Retinal fundus photograph · 1659x2212:
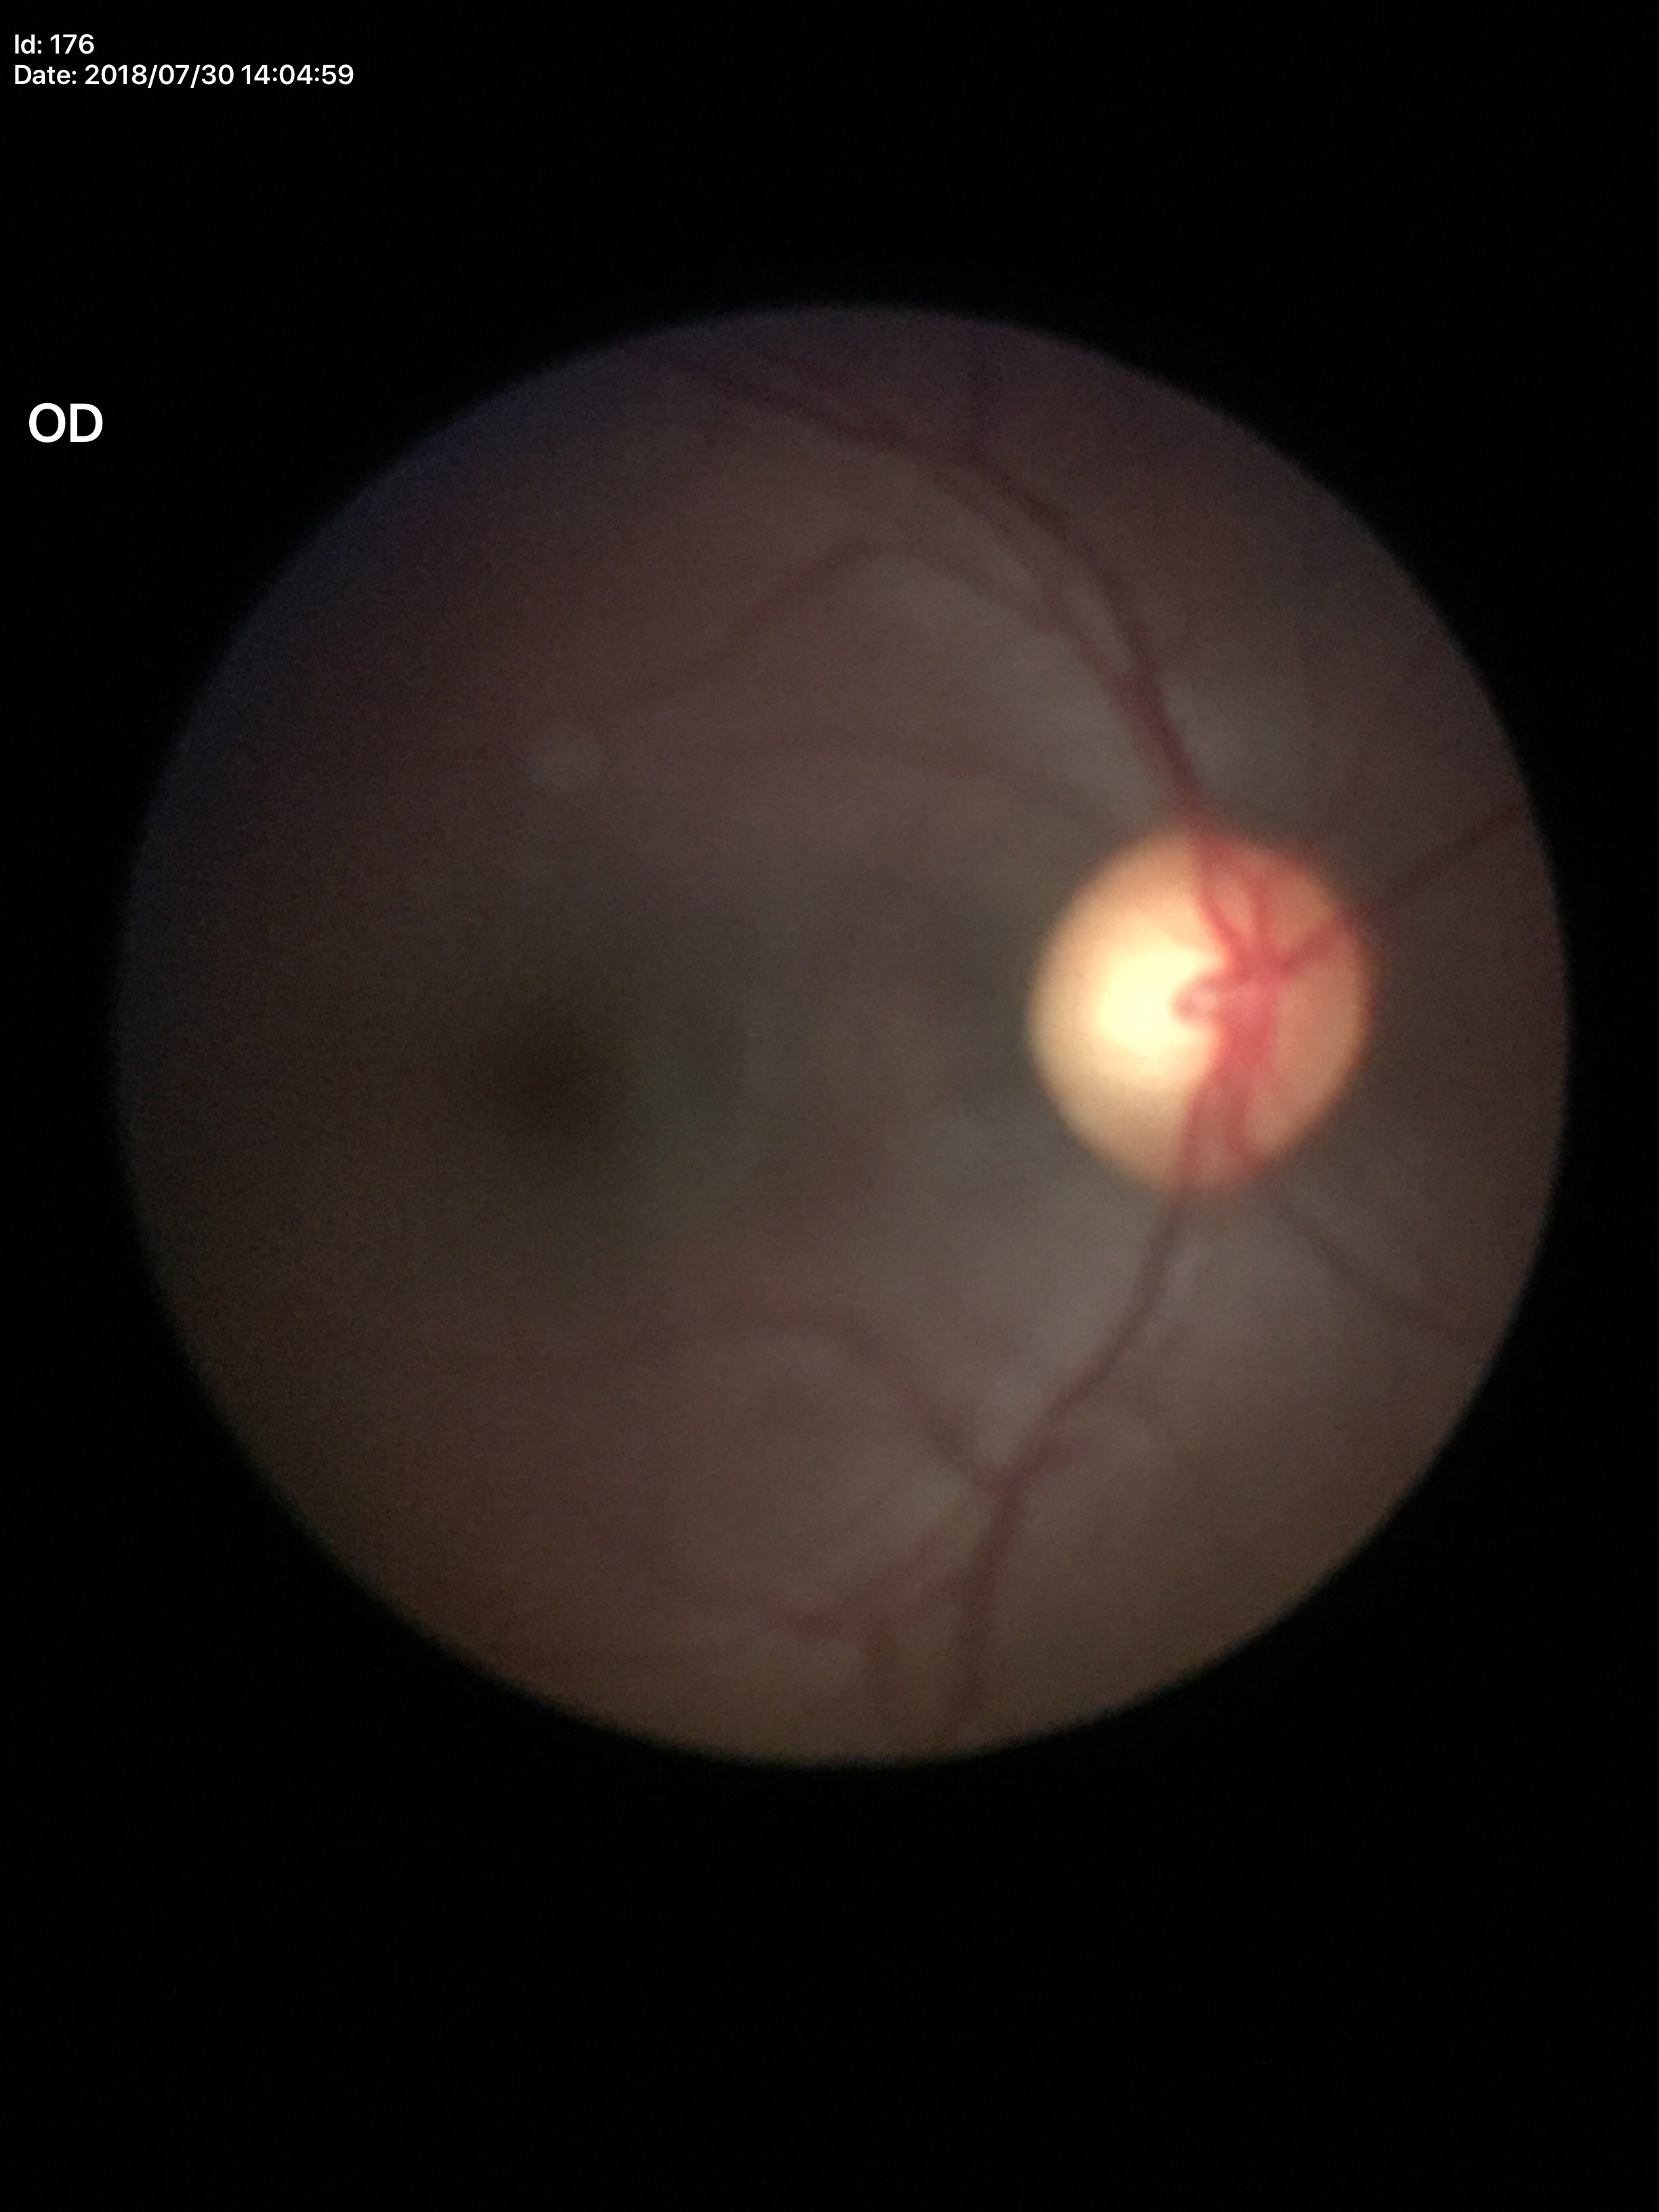
{
  "glaucoma_decision": "not suspect",
  "vcdr": "0.61"
}